Retinal fundus photograph:
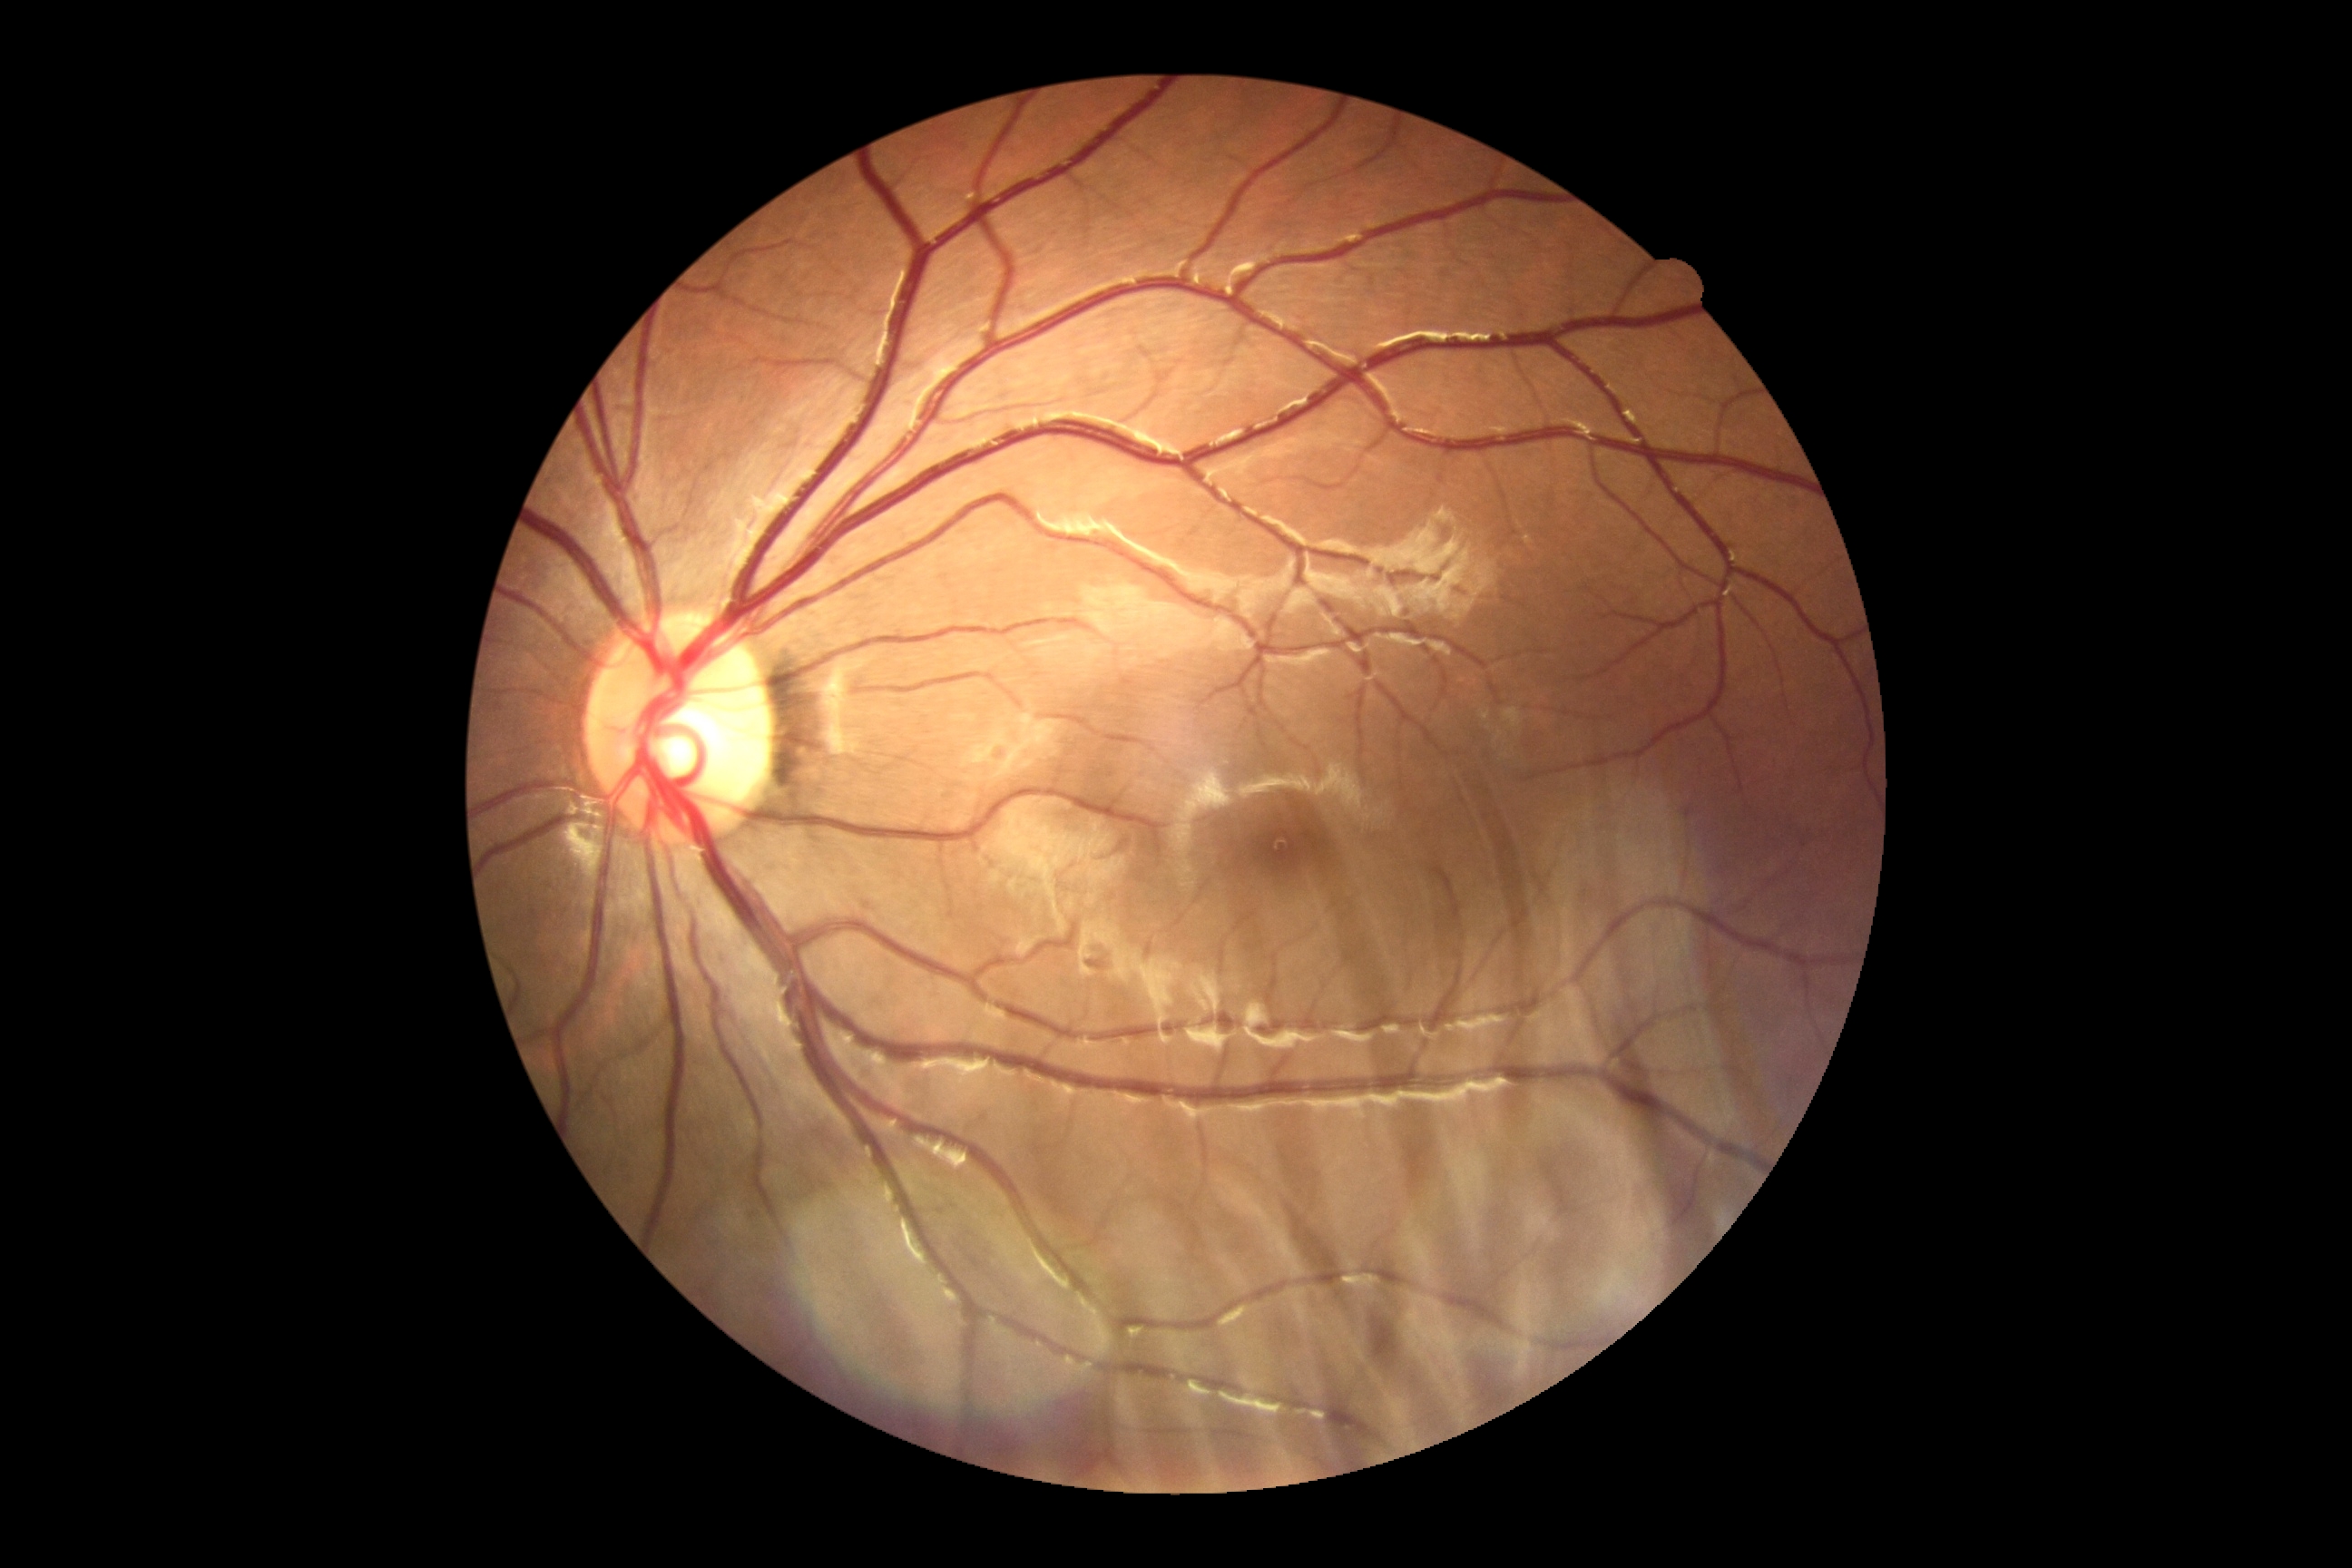
DR grade is 0 (no apparent retinopathy).